Infant wide-field fundus photograph.
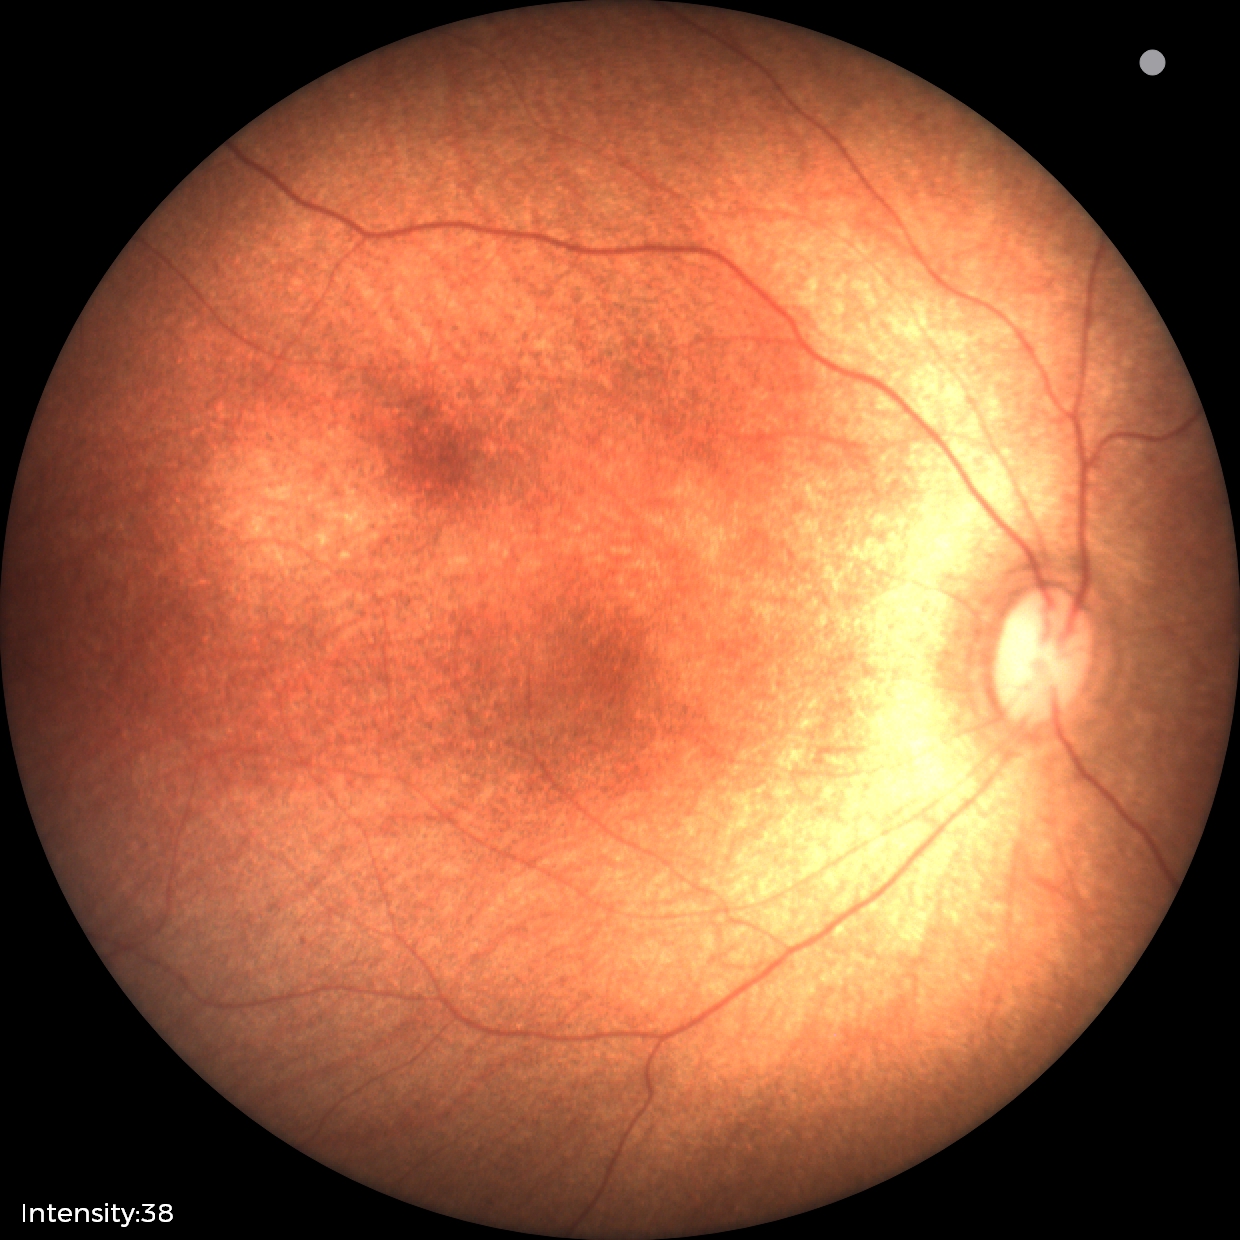

Normal screening examination.